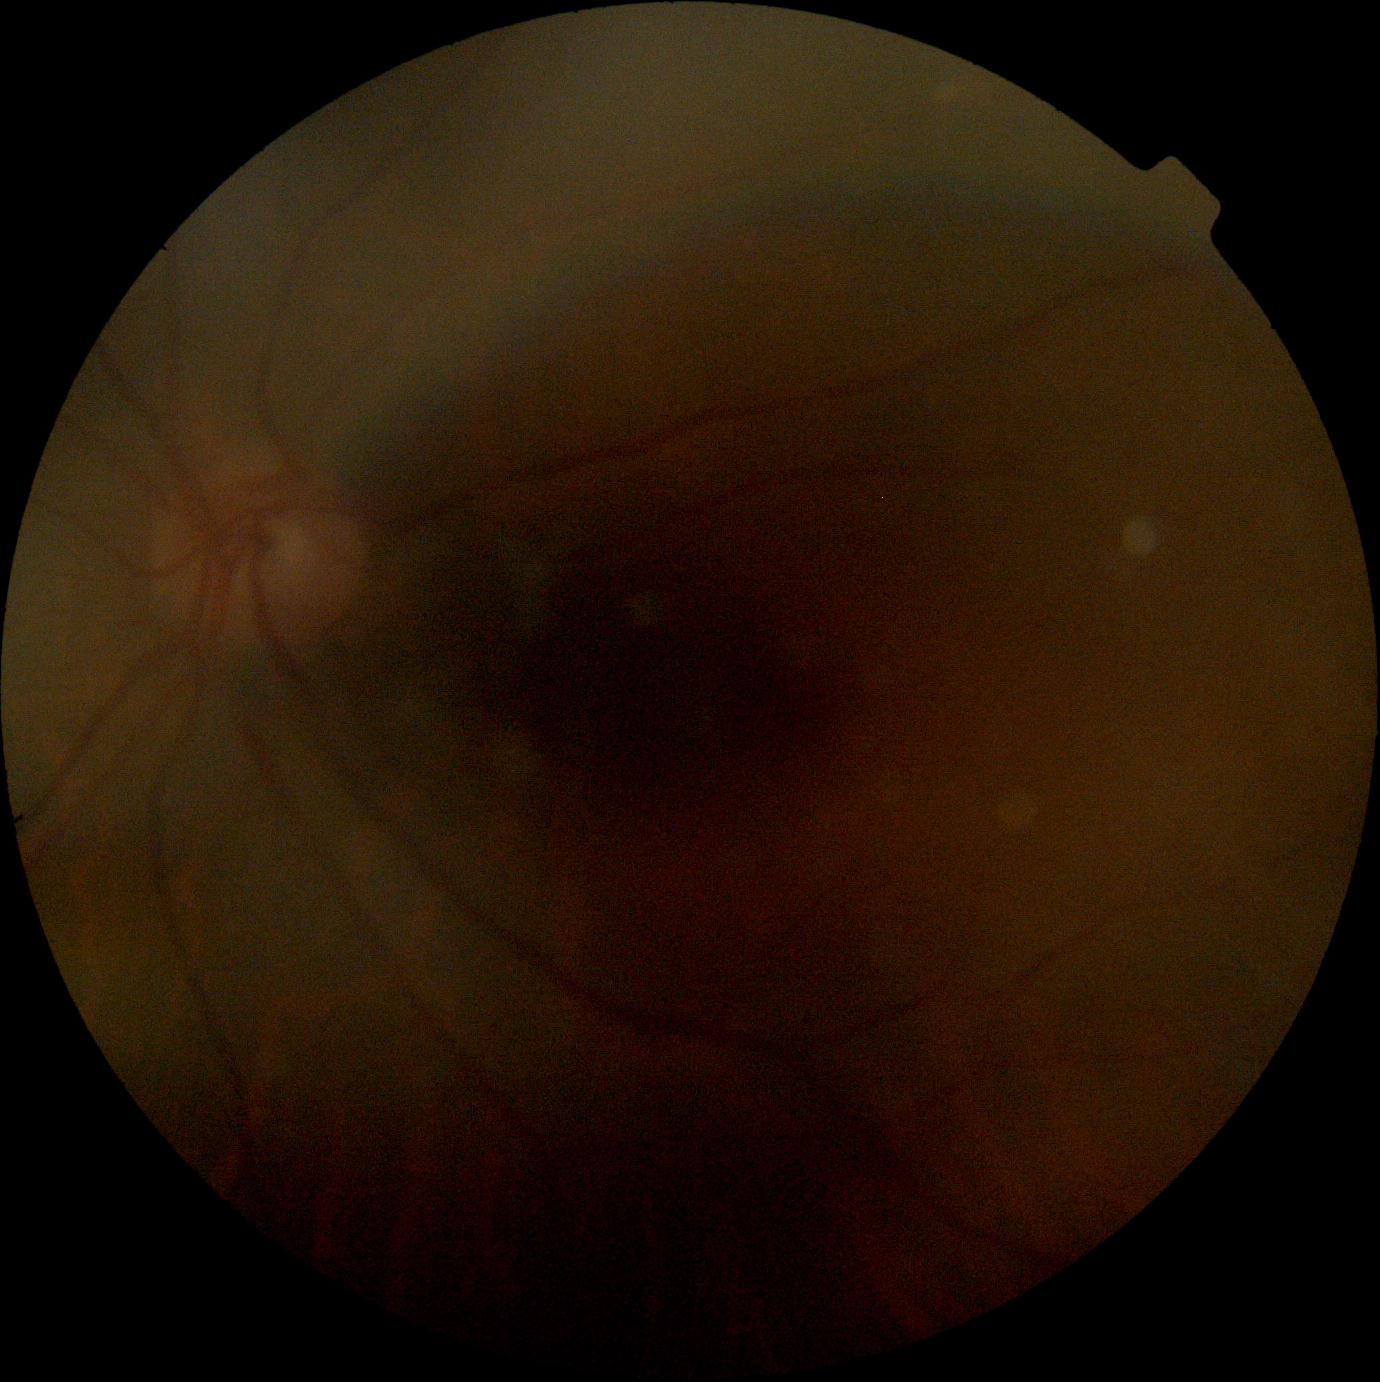

diabetic retinopathy = no apparent retinopathy (grade 0) | DR impression = no DR findings.